45° field of view, color fundus image:
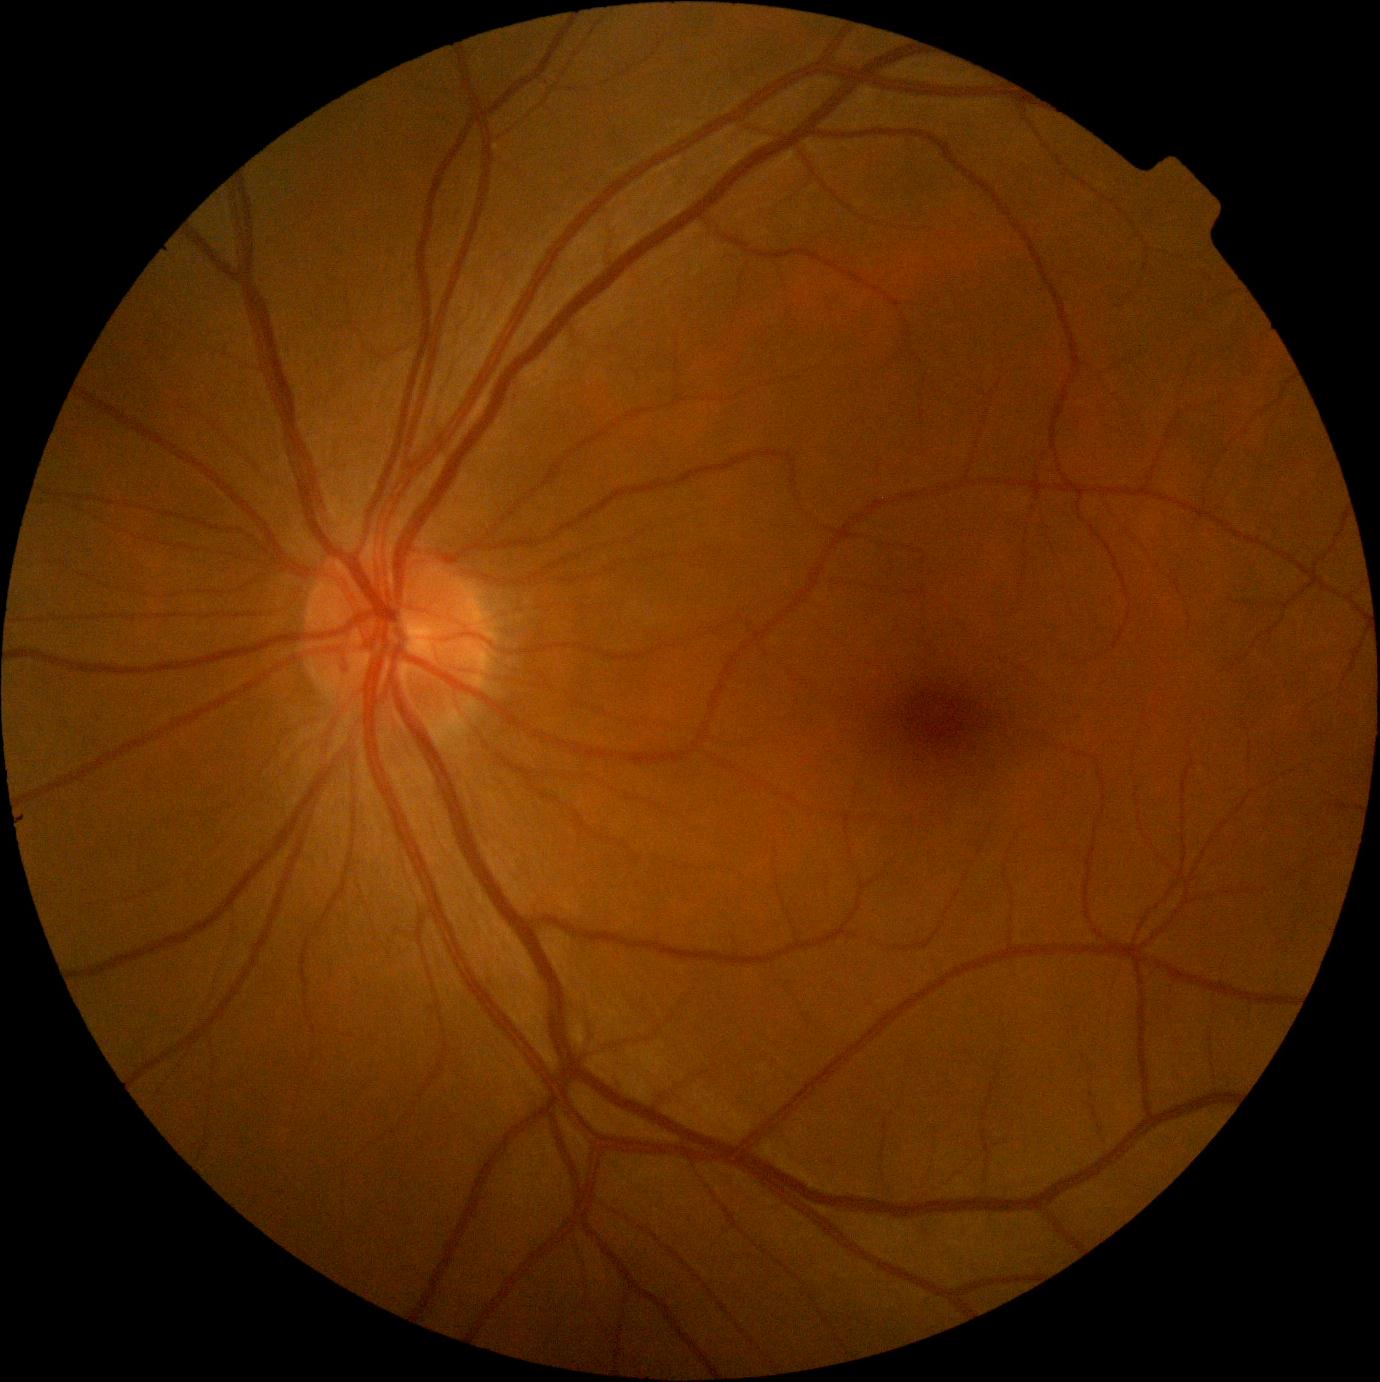 retinopathy=grade 0 (no apparent retinopathy).